CFP: 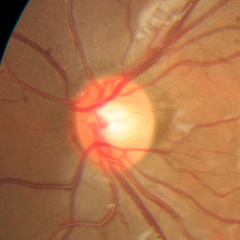 Optic disc appearance consistent with no evidence of glaucoma.